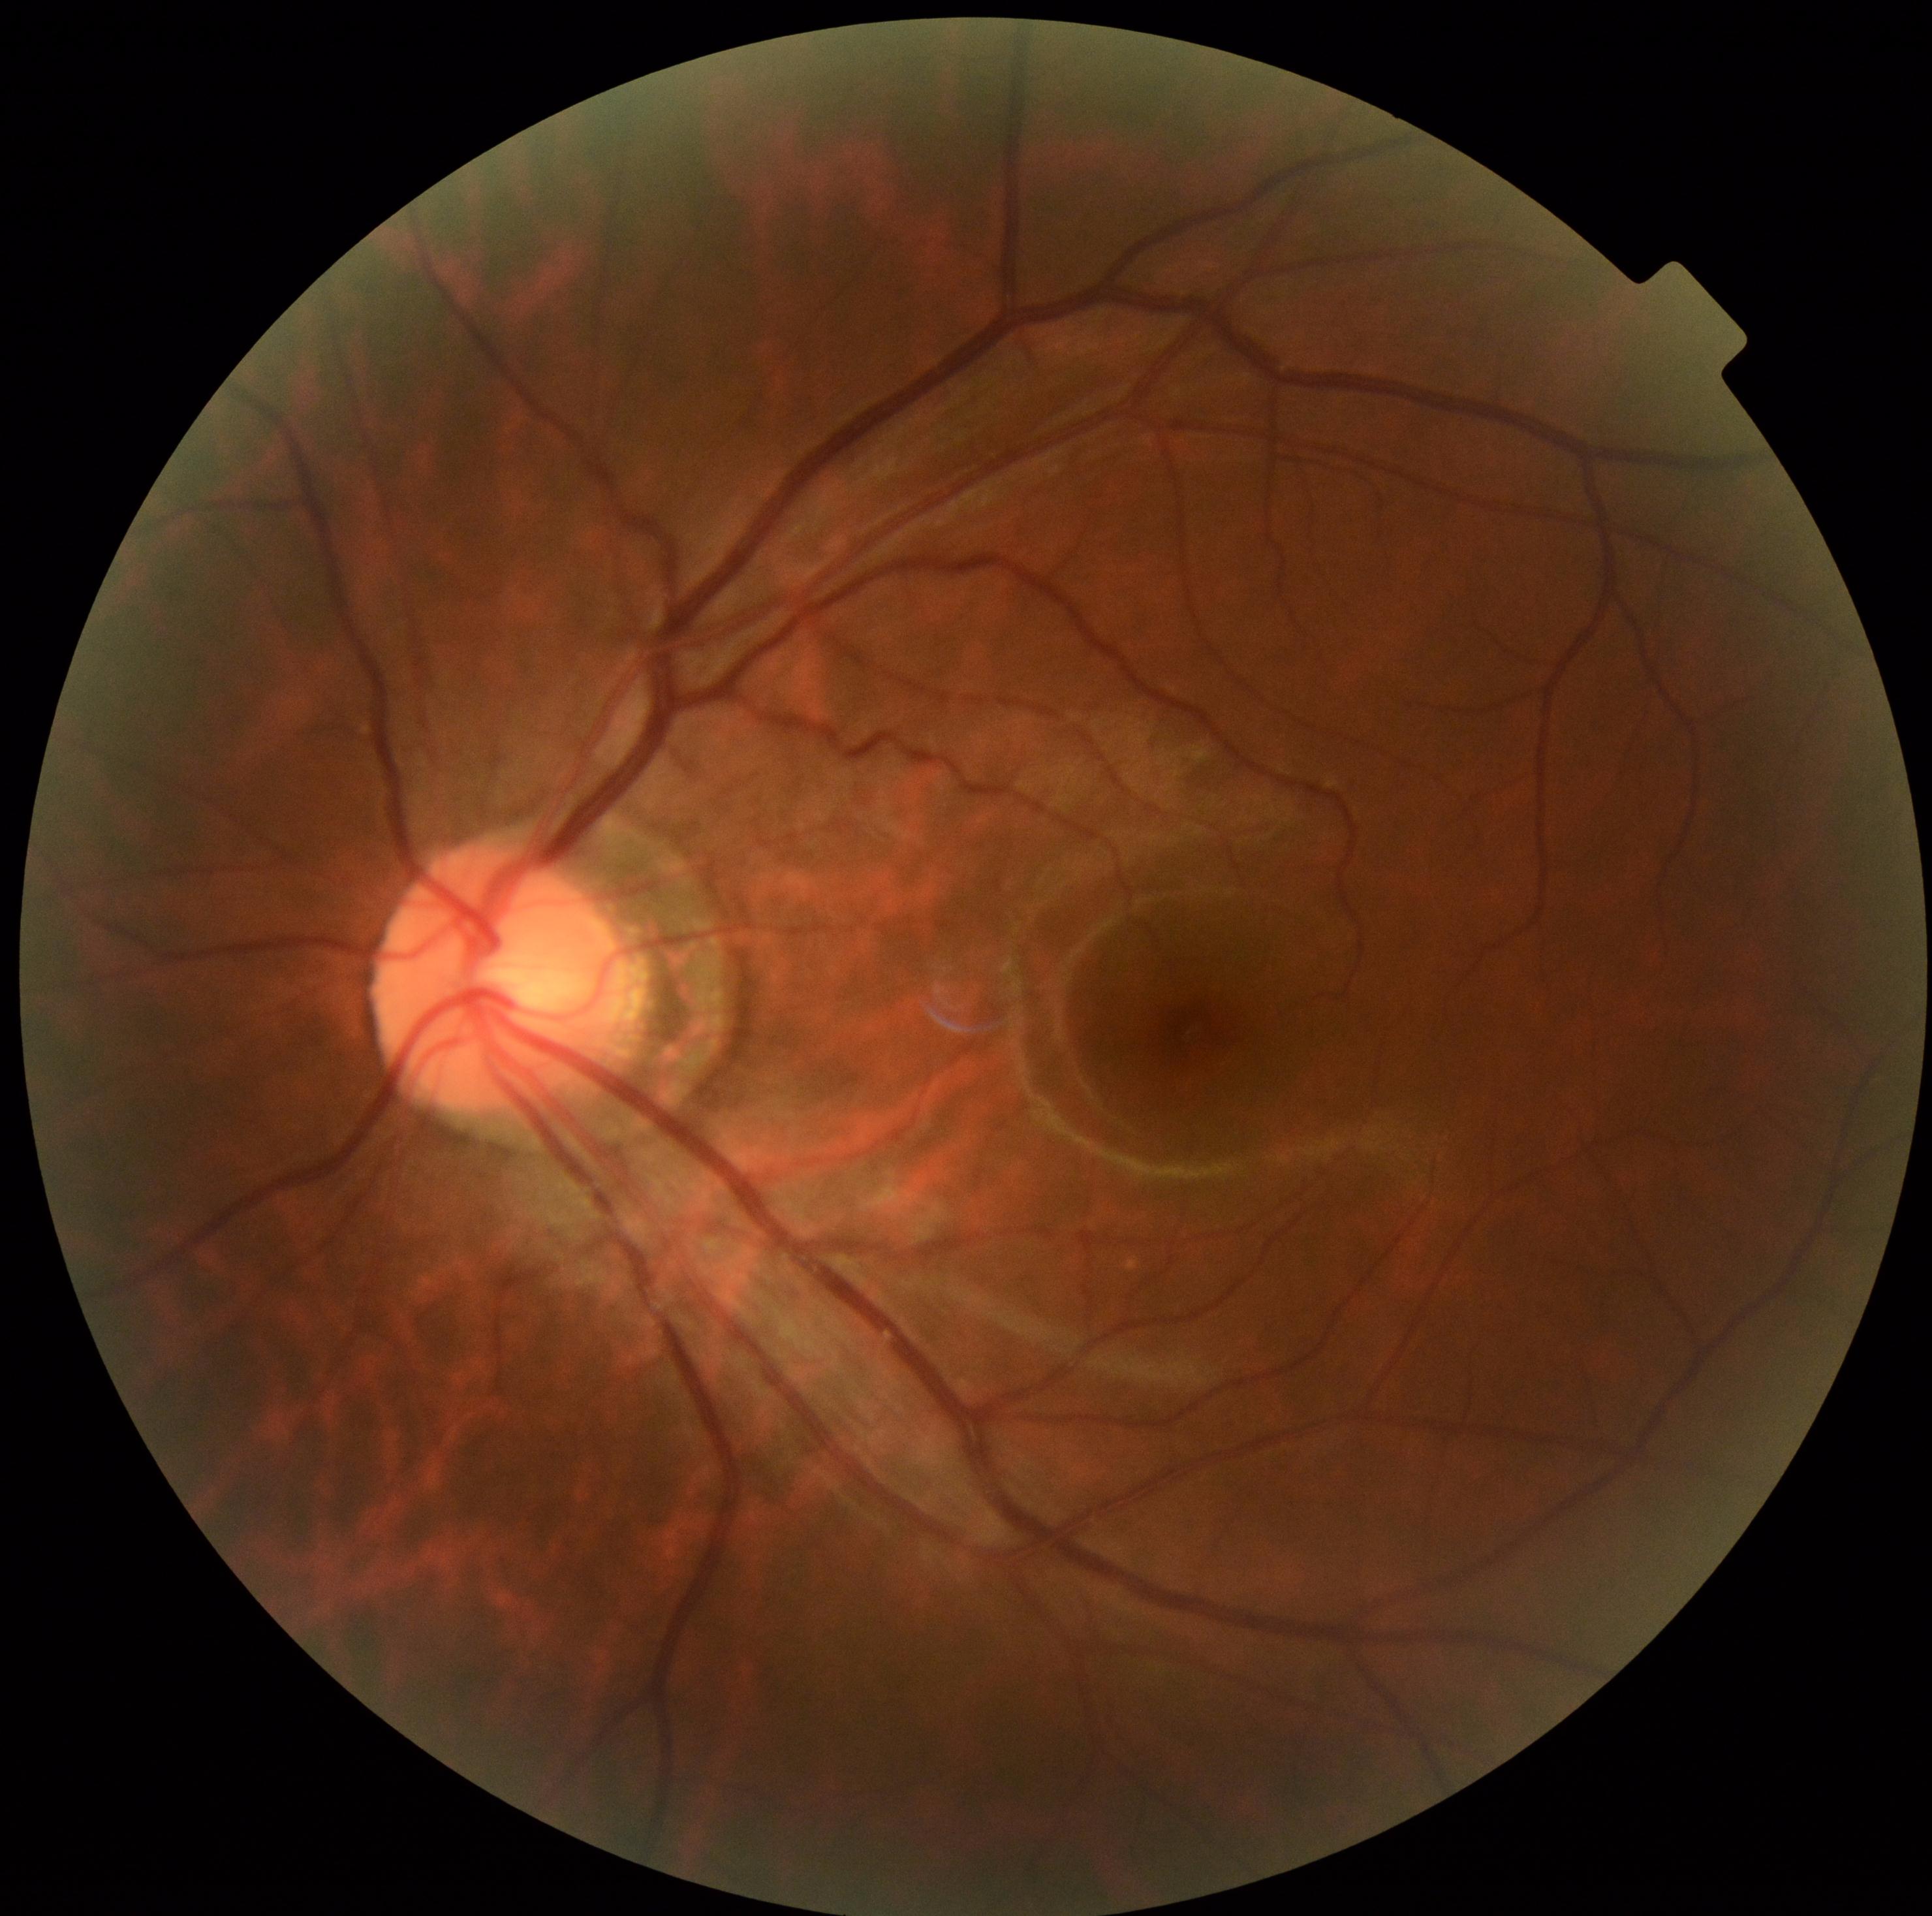

DR impression: no apparent DR; retinopathy grade: 0 (no apparent retinopathy).